Image size 2048x1536.
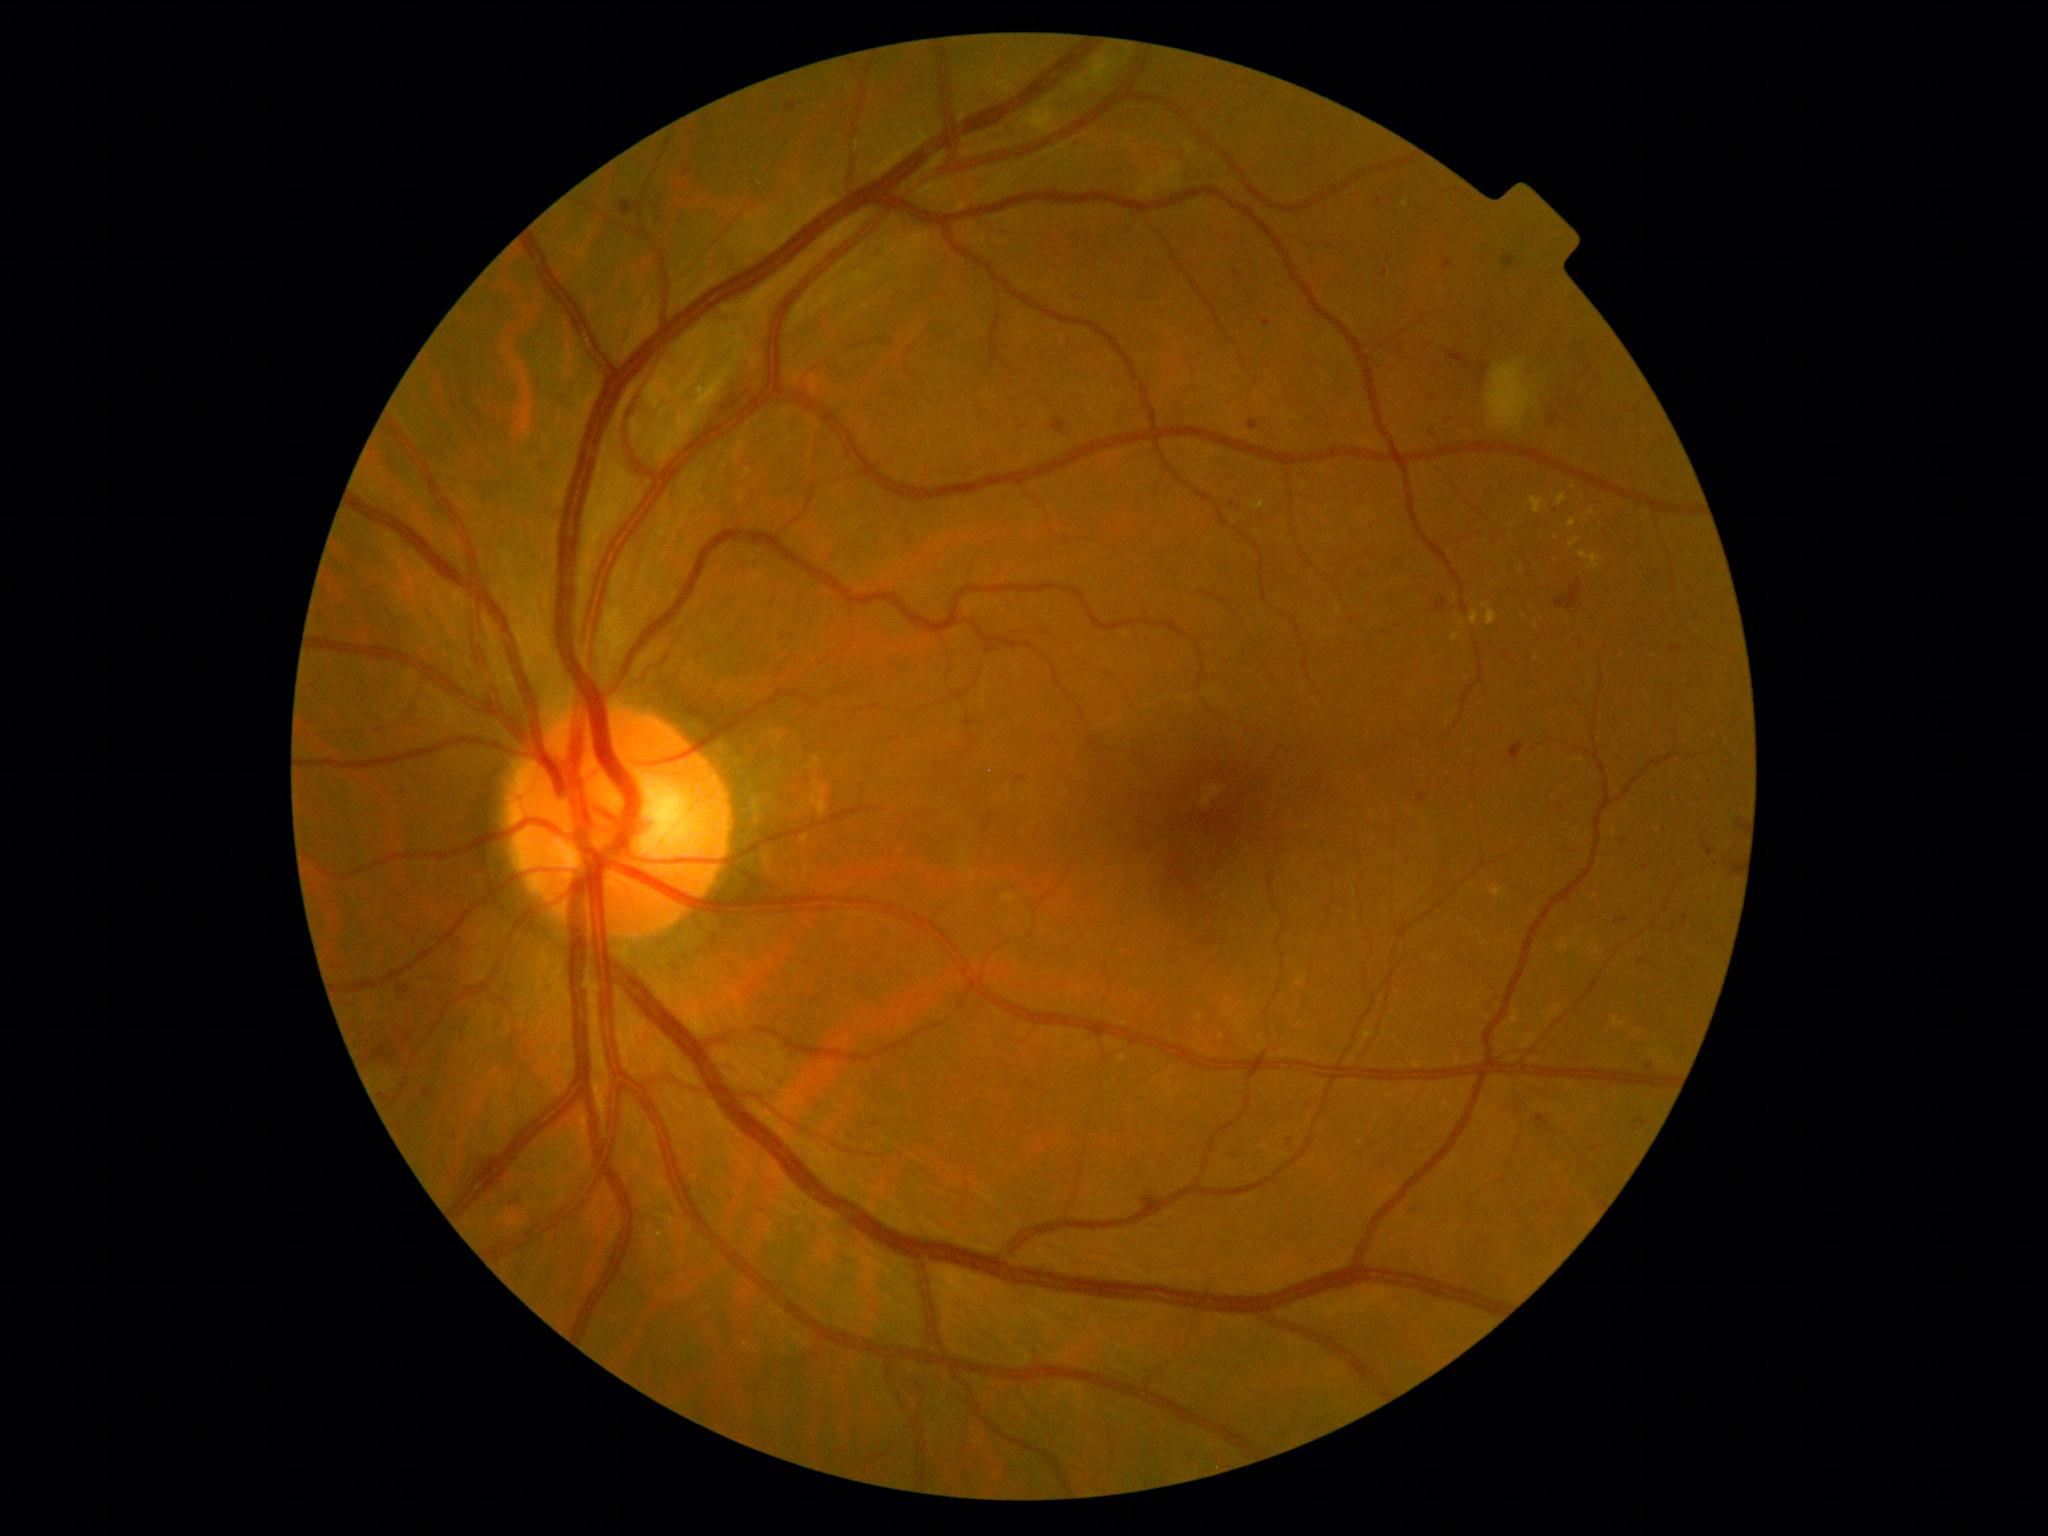

Findings:
• retinopathy: moderate NPDR (grade 2)